50° FOV, posterior pole view, captured after pupil dilation, Topcon TRC-50DX, 2228 by 1652 pixels:
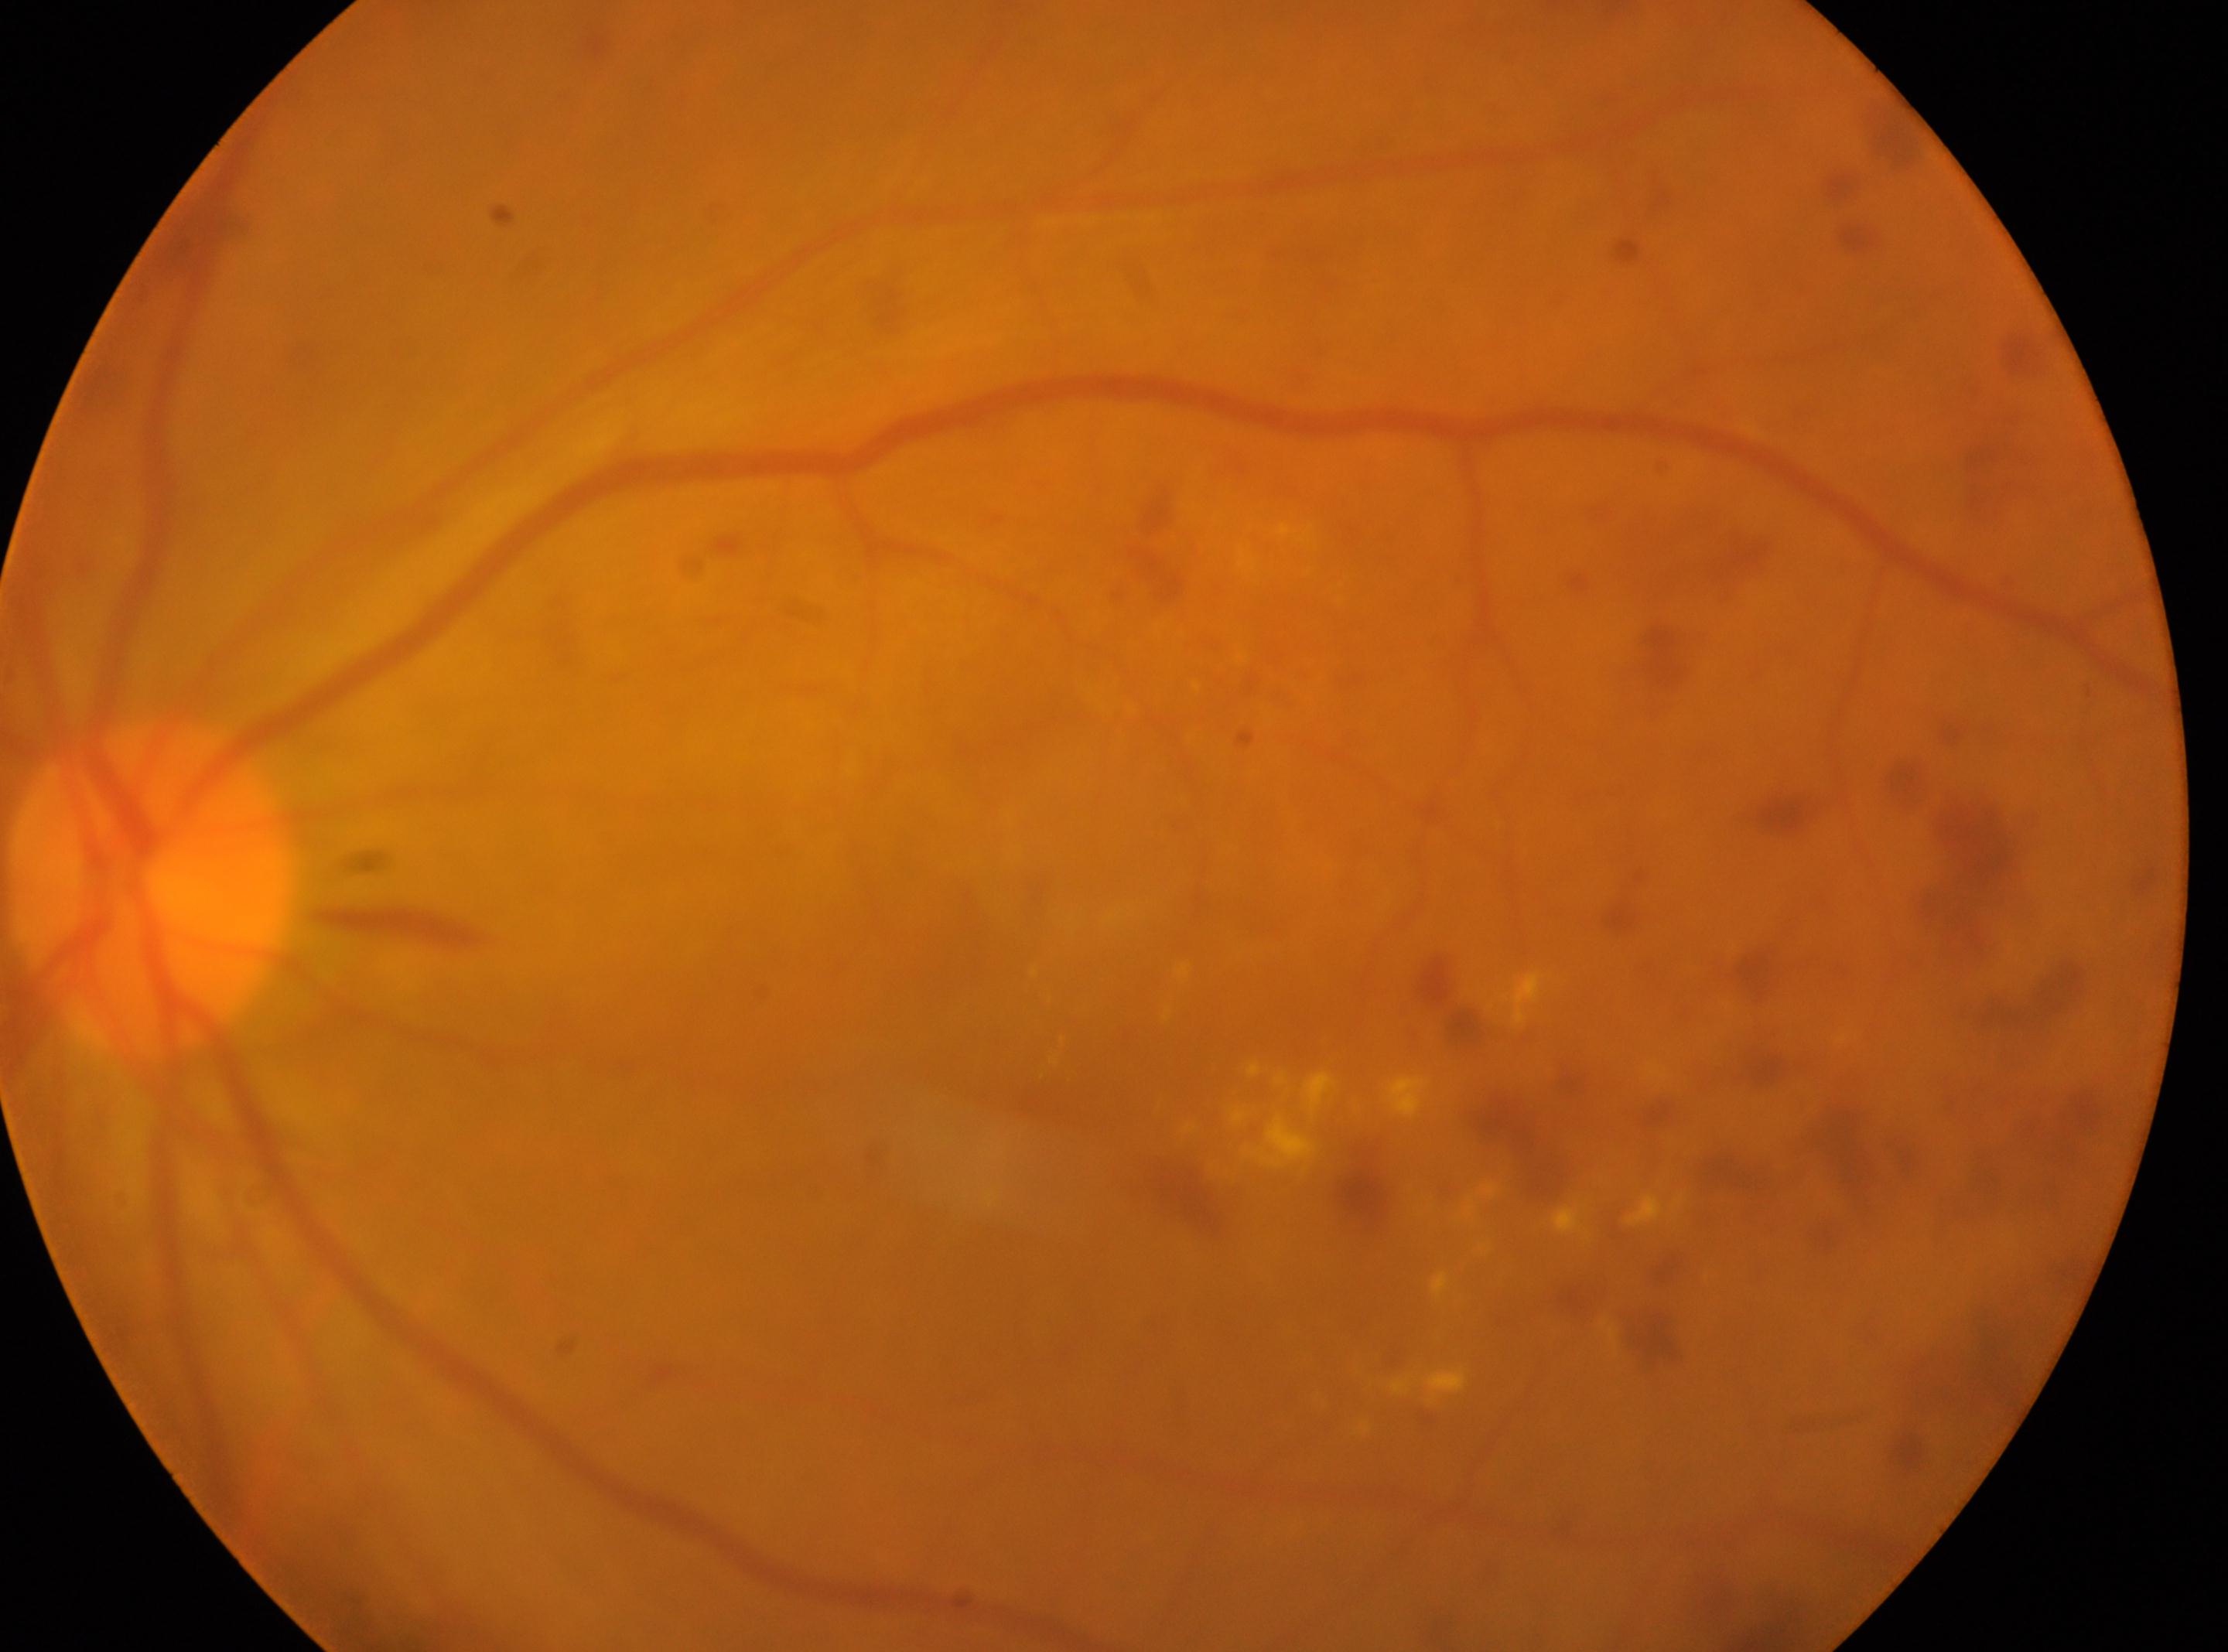 The foveal center is at x=1112, y=1066. Optic disc located at x=149, y=885. DR severity is grade 3 (severe NPDR). Eye: left. DR class: non-proliferative diabetic retinopathy.